2048 by 1536 pixels · CFP — 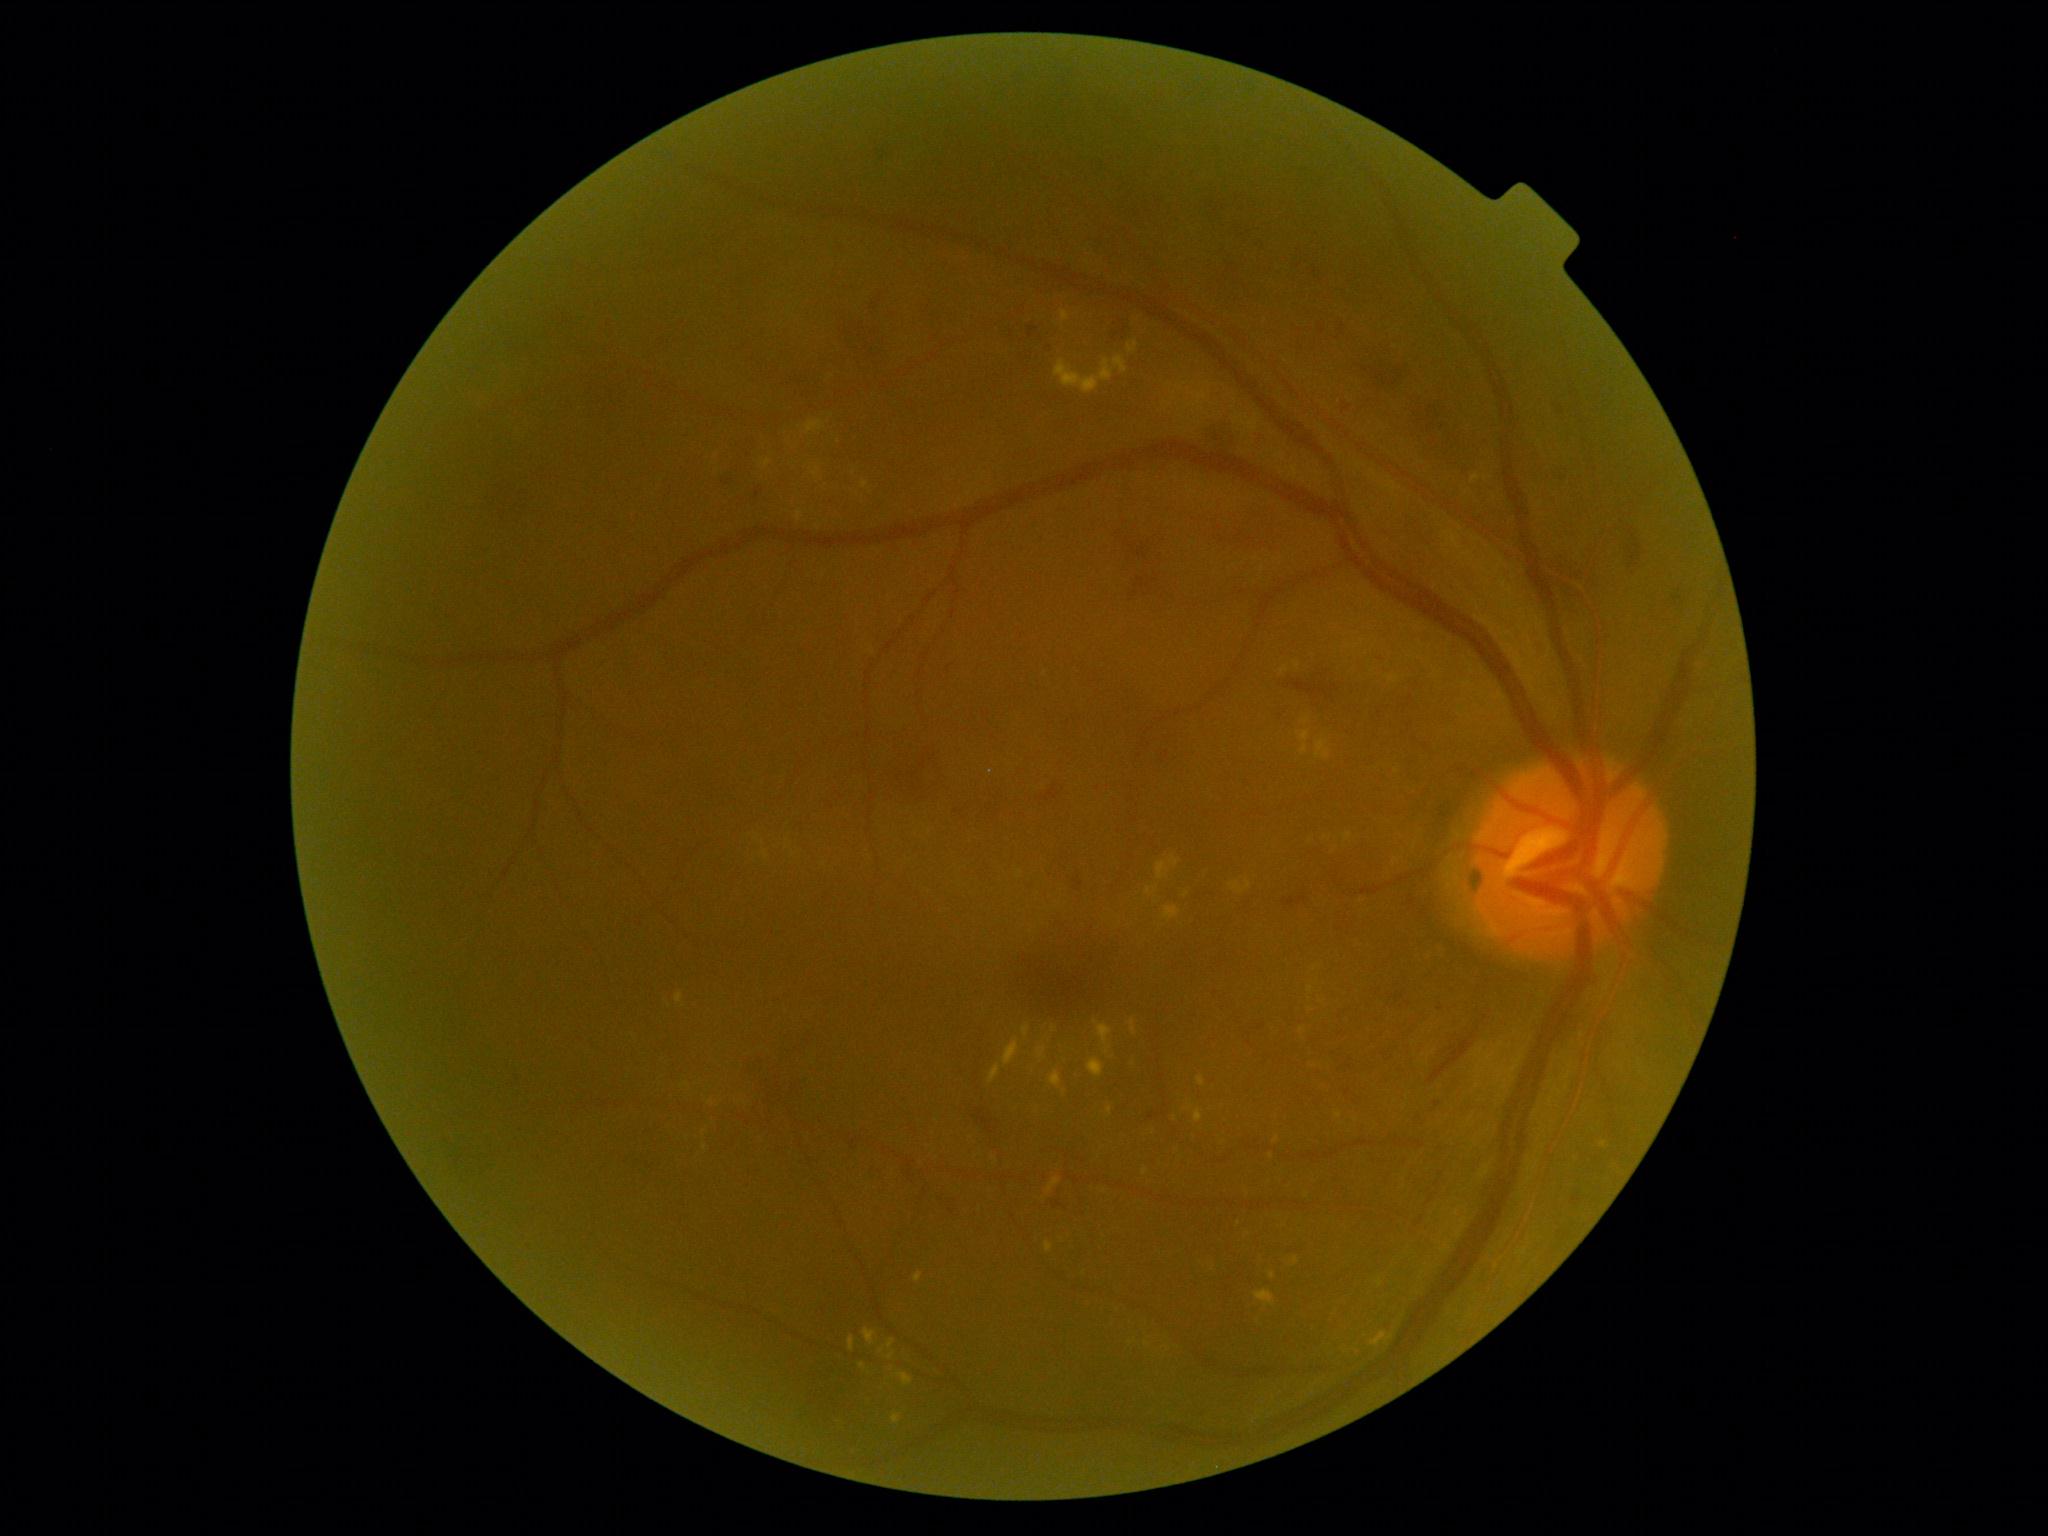

Diabetic retinopathy (DR) is grade 2 (moderate NPDR) — more than just microaneurysms but less than severe NPDR
Representative lesions:
hard exudates (EXs) (continued): <box>1050,1071,1062,1089</box> | <box>1294,662,1301,670</box> | <box>989,1064,1002,1084</box> | <box>1315,739,1331,761</box> | <box>848,1337,855,1352</box> | <box>1023,1026,1030,1037</box> | <box>893,1414,901,1425</box> | <box>805,421,827,435</box> | <box>1169,857,1181,868</box> | <box>1055,360,1115,394</box> | <box>858,1364,867,1369</box> | <box>1281,666,1288,675</box> | <box>1061,311,1070,322</box>
Small EXs near <point>1187, 895</point> | <point>1271, 1157</point> | <point>1303, 1031</point> | <point>1263, 569</point> | <point>1311, 990</point> | <point>892, 1370</point>
soft exudates (SEs): none detected
hemorrhages (HEs) (continued): <box>1287,680,1331,699</box> | <box>1673,597,1682,602</box> | <box>1027,325,1039,338</box> | <box>1201,423,1241,456</box> | <box>1086,229,1131,265</box> | <box>1331,685,1340,692</box> | <box>887,751,943,806</box> | <box>722,480,734,486</box> | <box>1282,898,1307,908</box> | <box>848,327,897,373</box> | <box>755,488,764,500</box> | <box>1129,540,1161,603</box> | <box>1628,540,1642,569</box>
Small HEs near <point>1124, 330</point> | <point>874, 304</point> | <point>1441, 1009</point> | <point>1167, 755</point>
microaneurysms (MAs) (continued): <box>1259,1024,1267,1030</box> | <box>1433,1101,1441,1111</box> | <box>1408,897,1417,907</box> | <box>1572,1195,1582,1205</box>
Small MAs near <point>1299, 266</point> | <point>1343, 327</point> | <point>1322, 330</point> | <point>1315, 273</point> | <point>1562, 412</point> | <point>1486, 1018</point>